2352 by 1568 pixels:
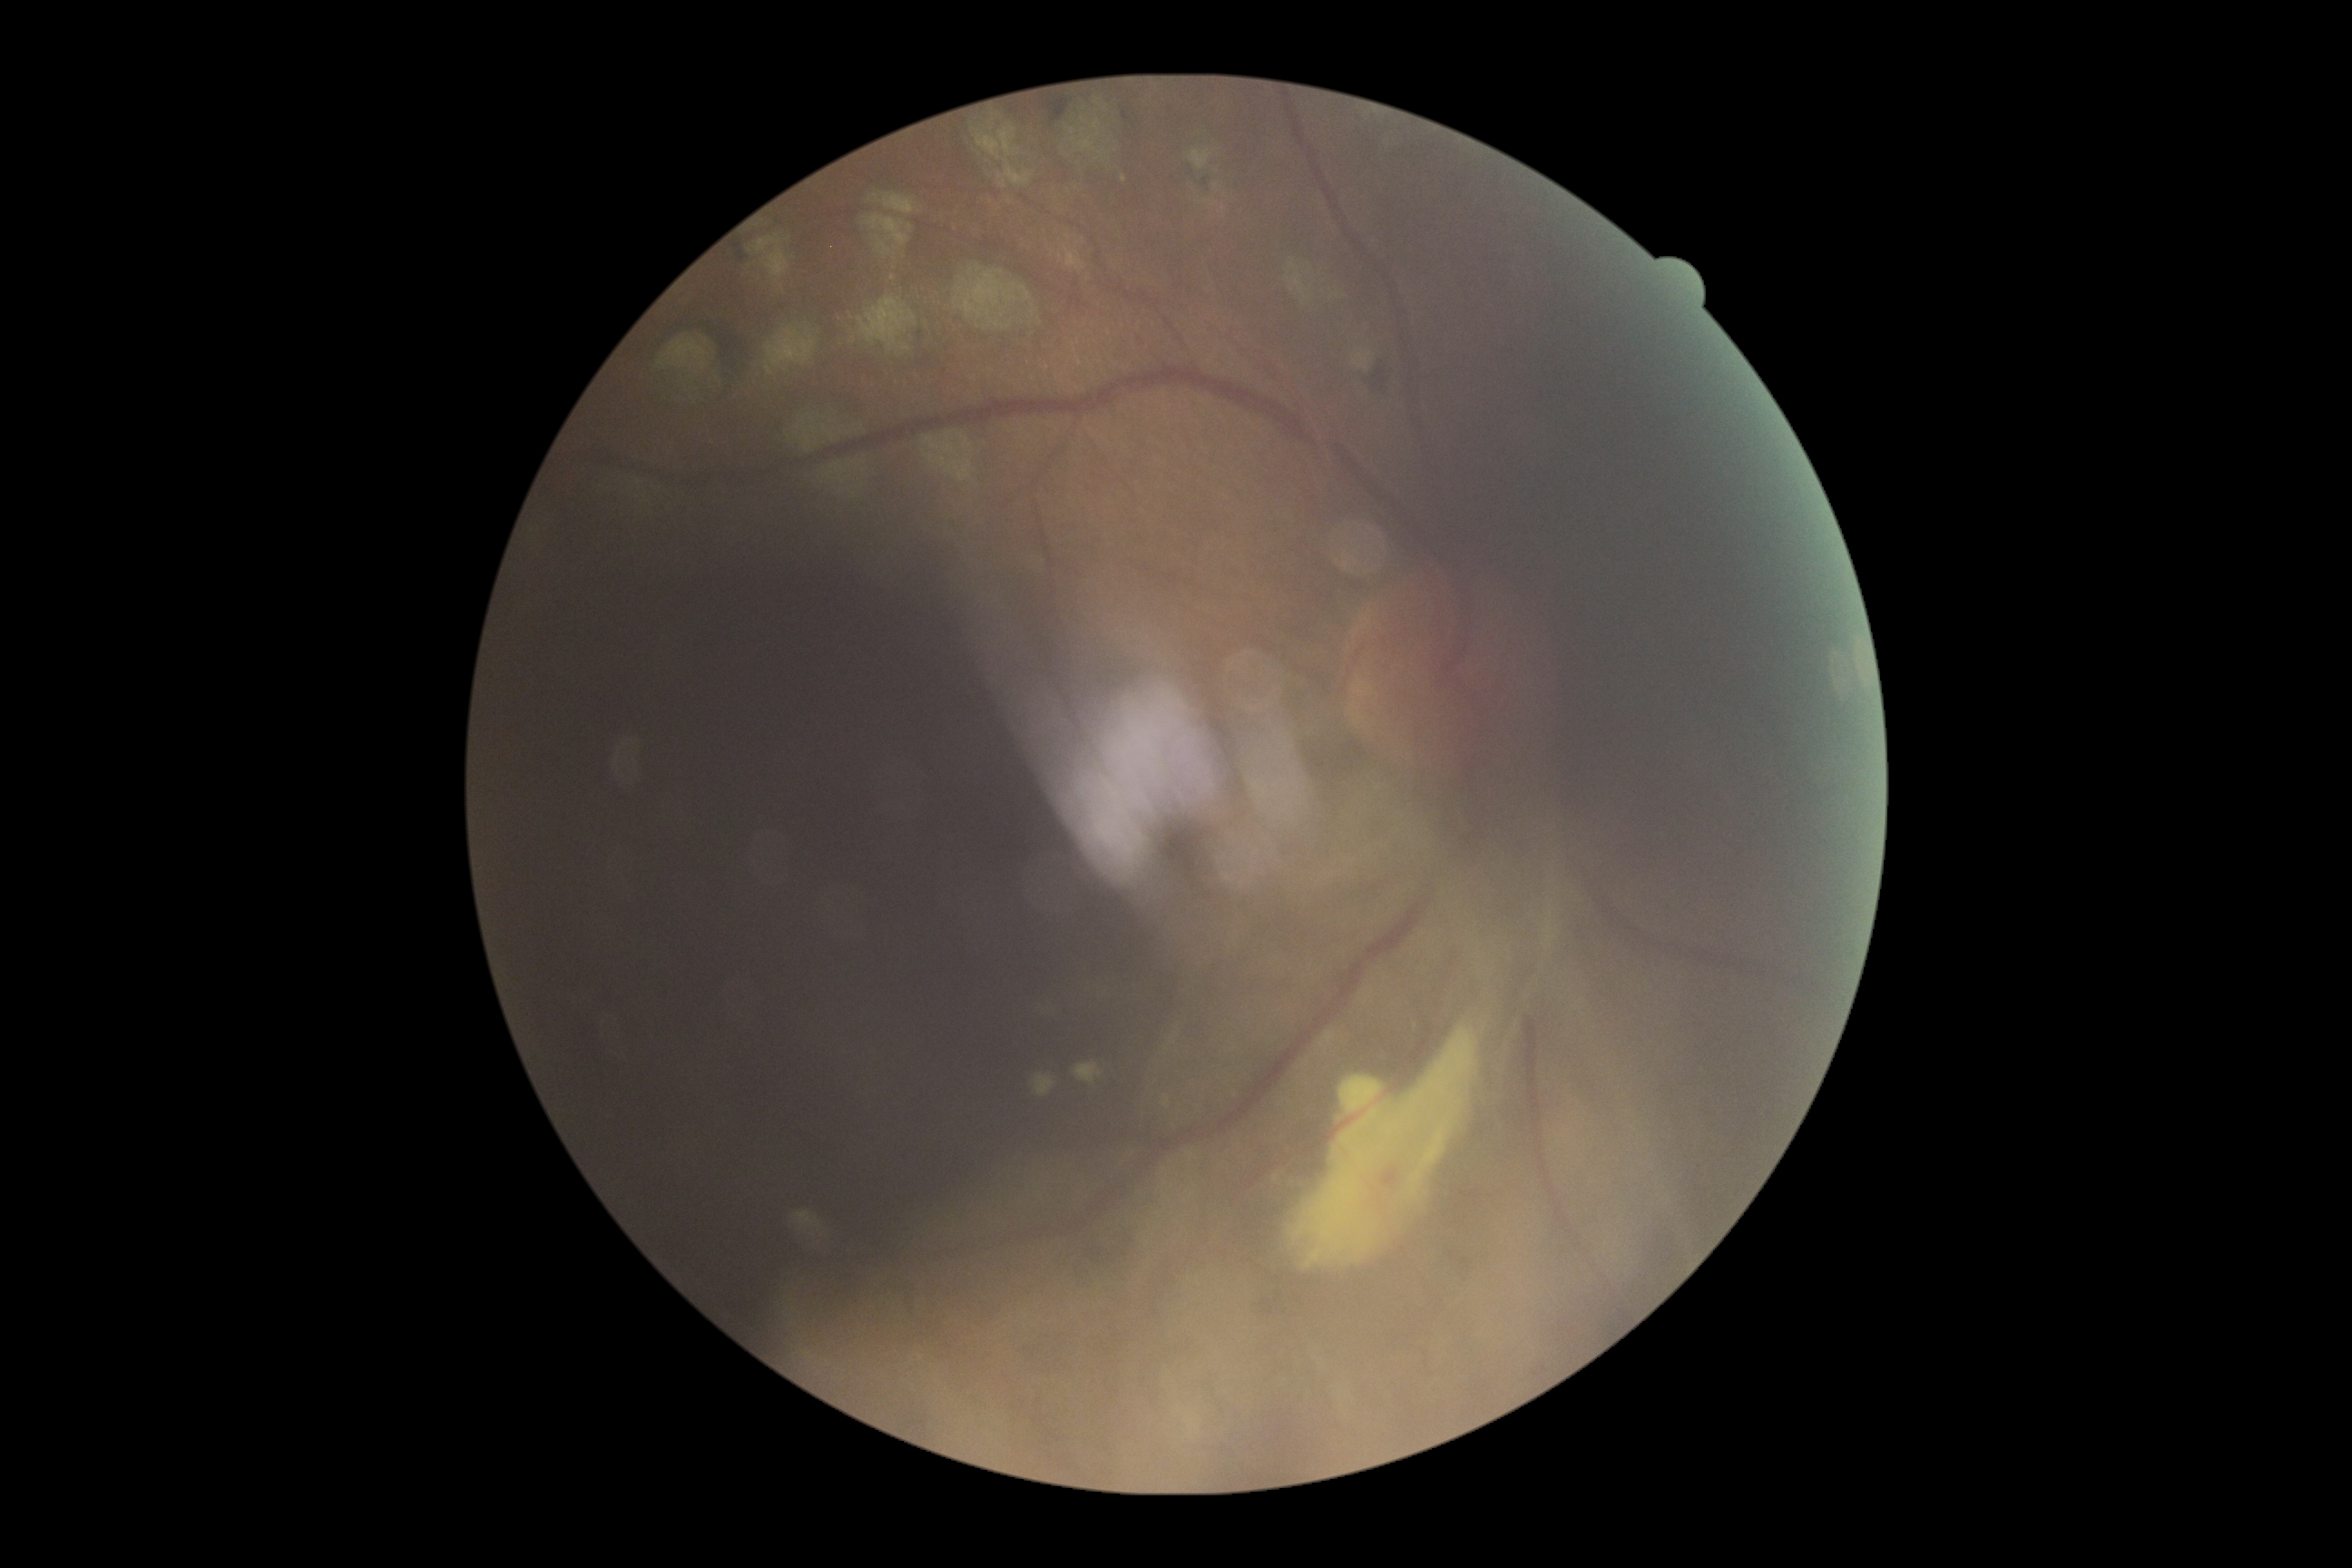 DR grade: 4 (PDR).